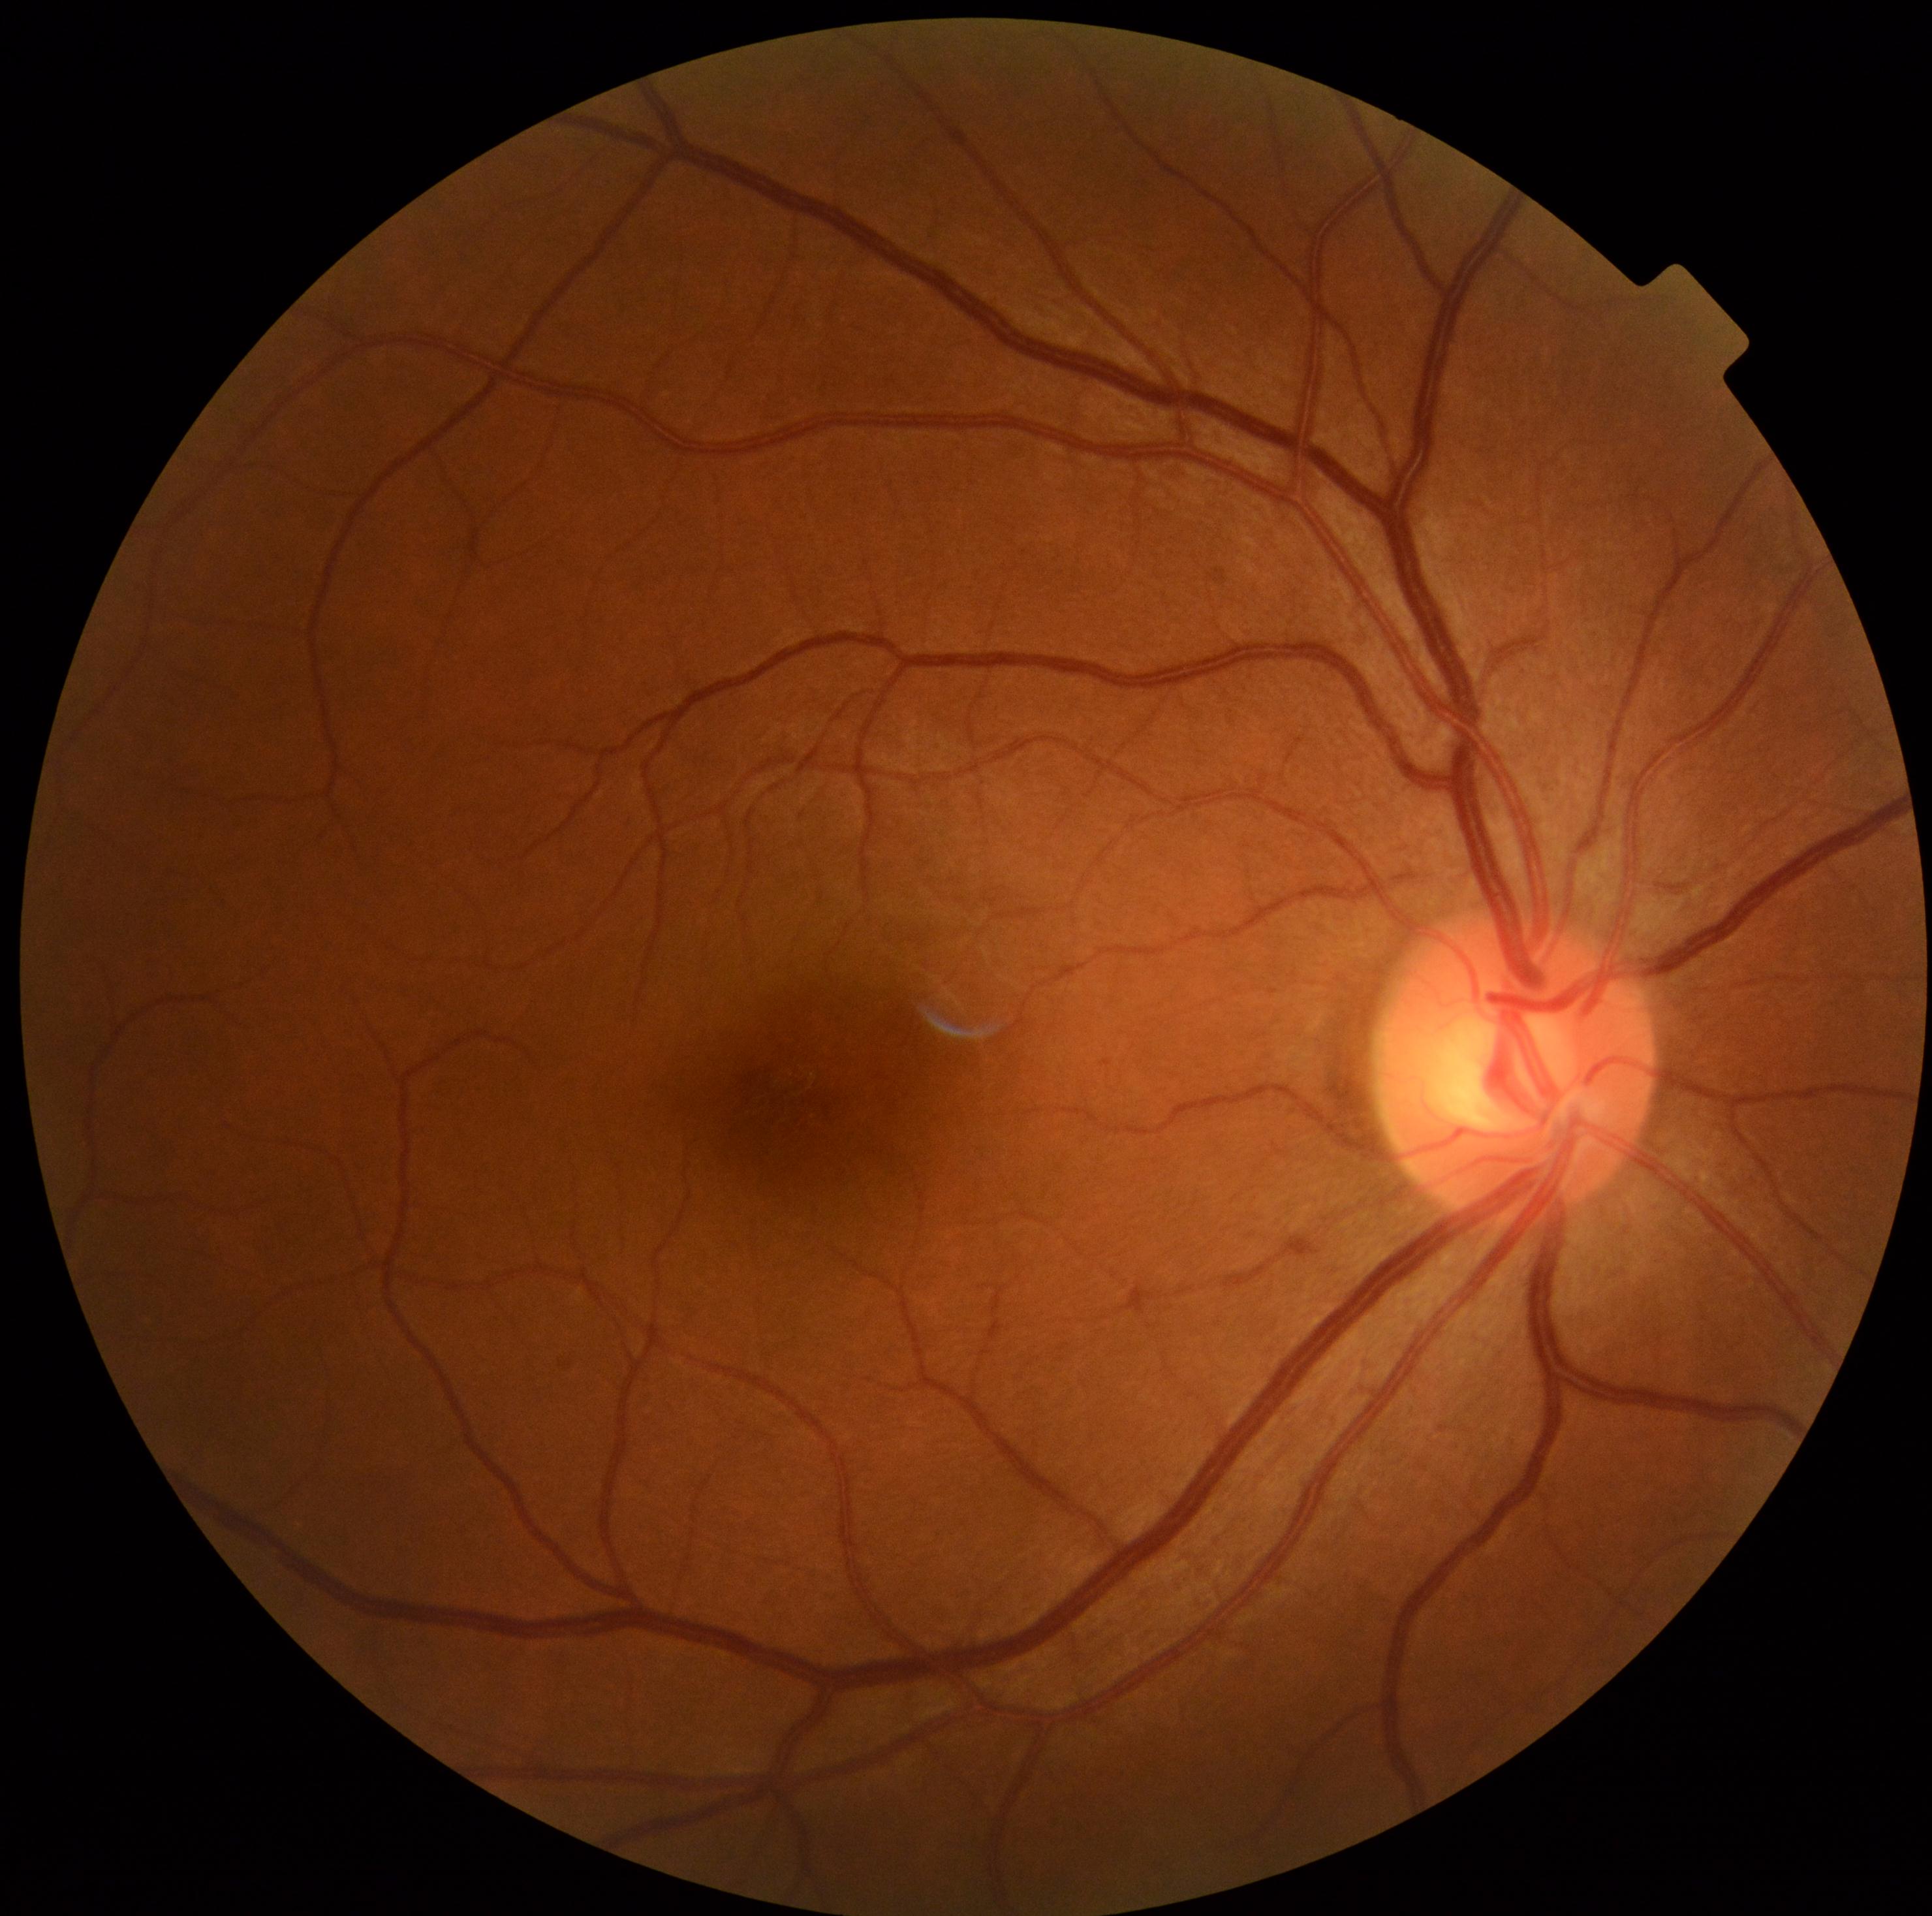

No DR findings.
Diabetic retinopathy (DR) is no apparent diabetic retinopathy (grade 0) — no visible signs of diabetic retinopathy.